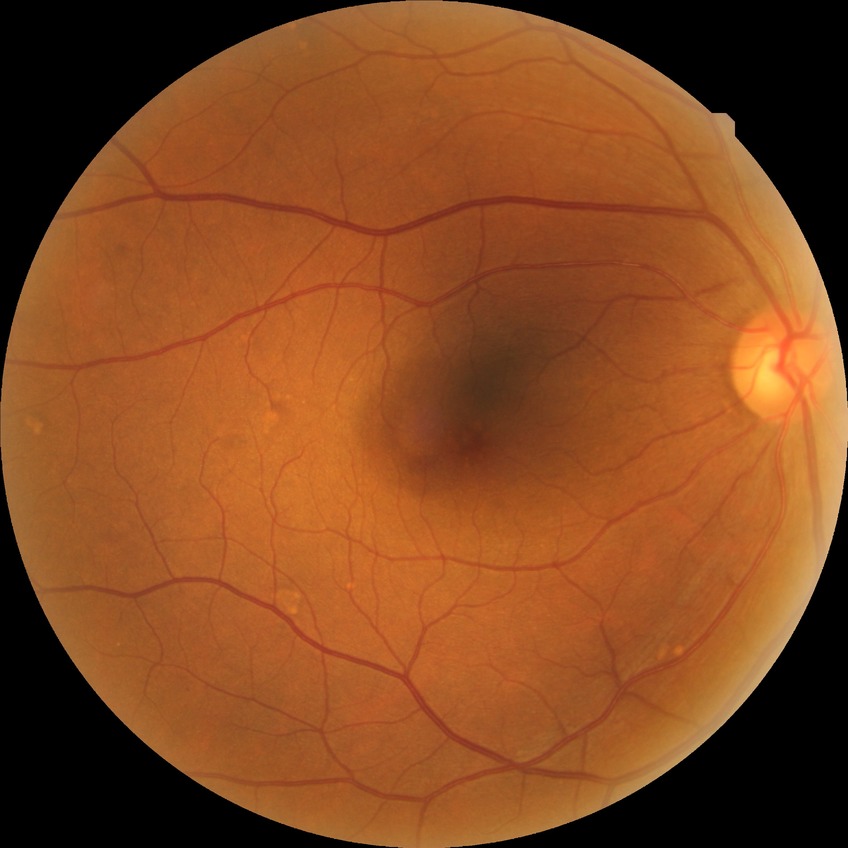
Diabetic retinopathy (DR) is NDR (no diabetic retinopathy).